Camera: Phoenix ICON (100° FOV) · 1240 x 1240 pixels · pediatric wide-field fundus photograph.
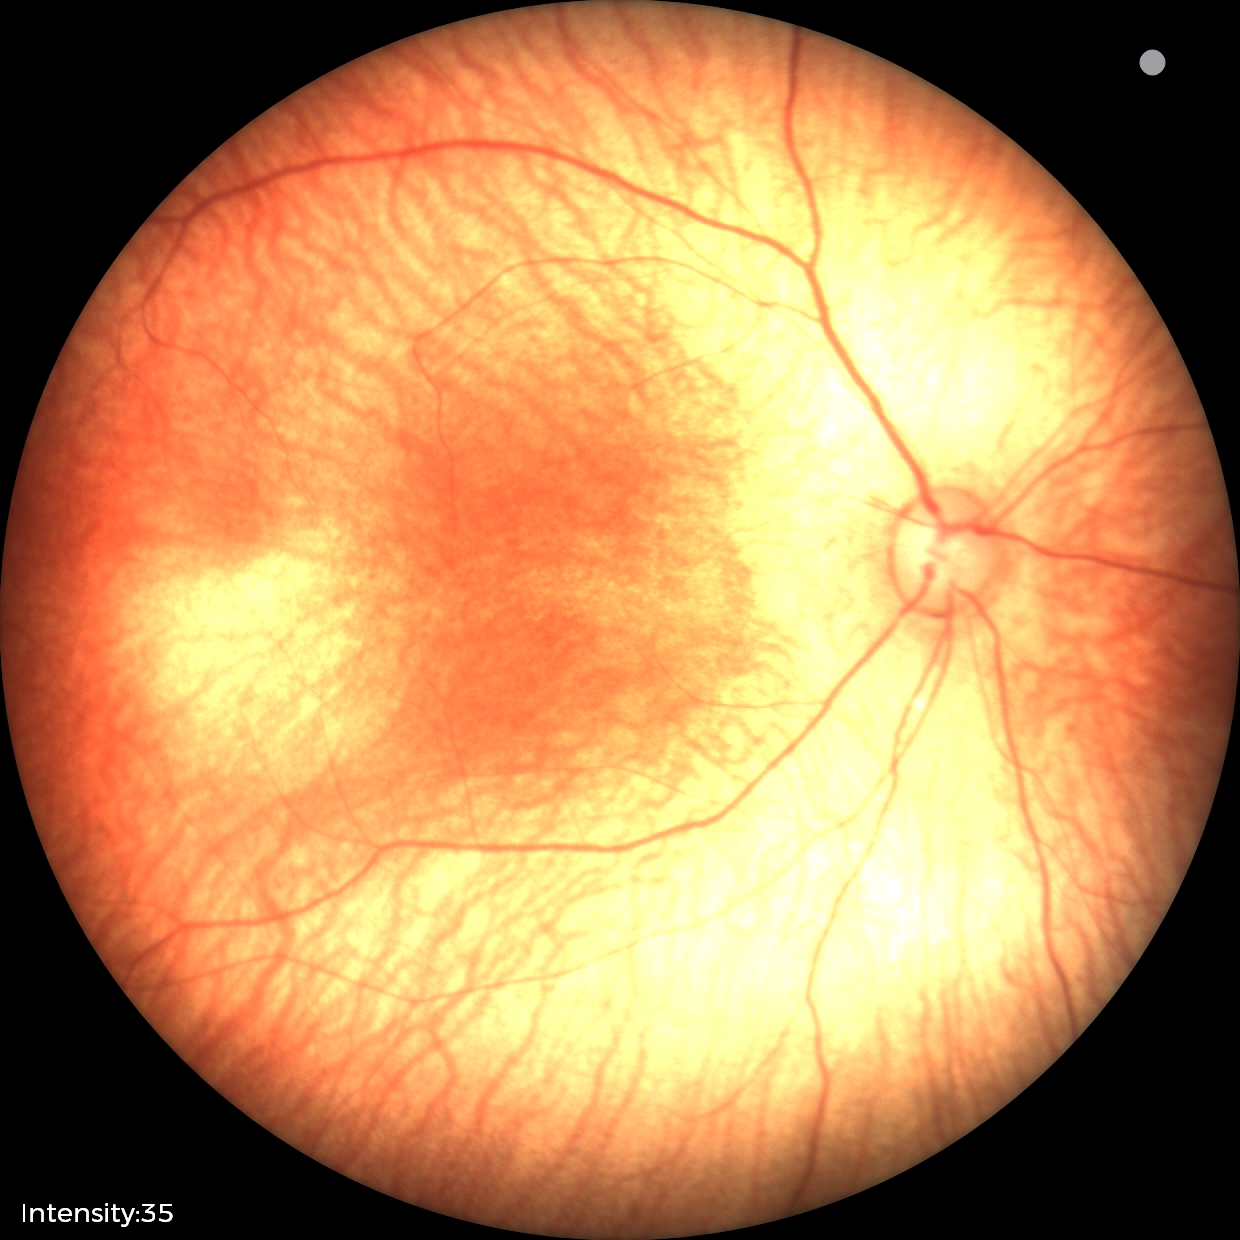 Screening examination with no abnormal retinal findings.